Retinal fundus photograph; 45° FOV
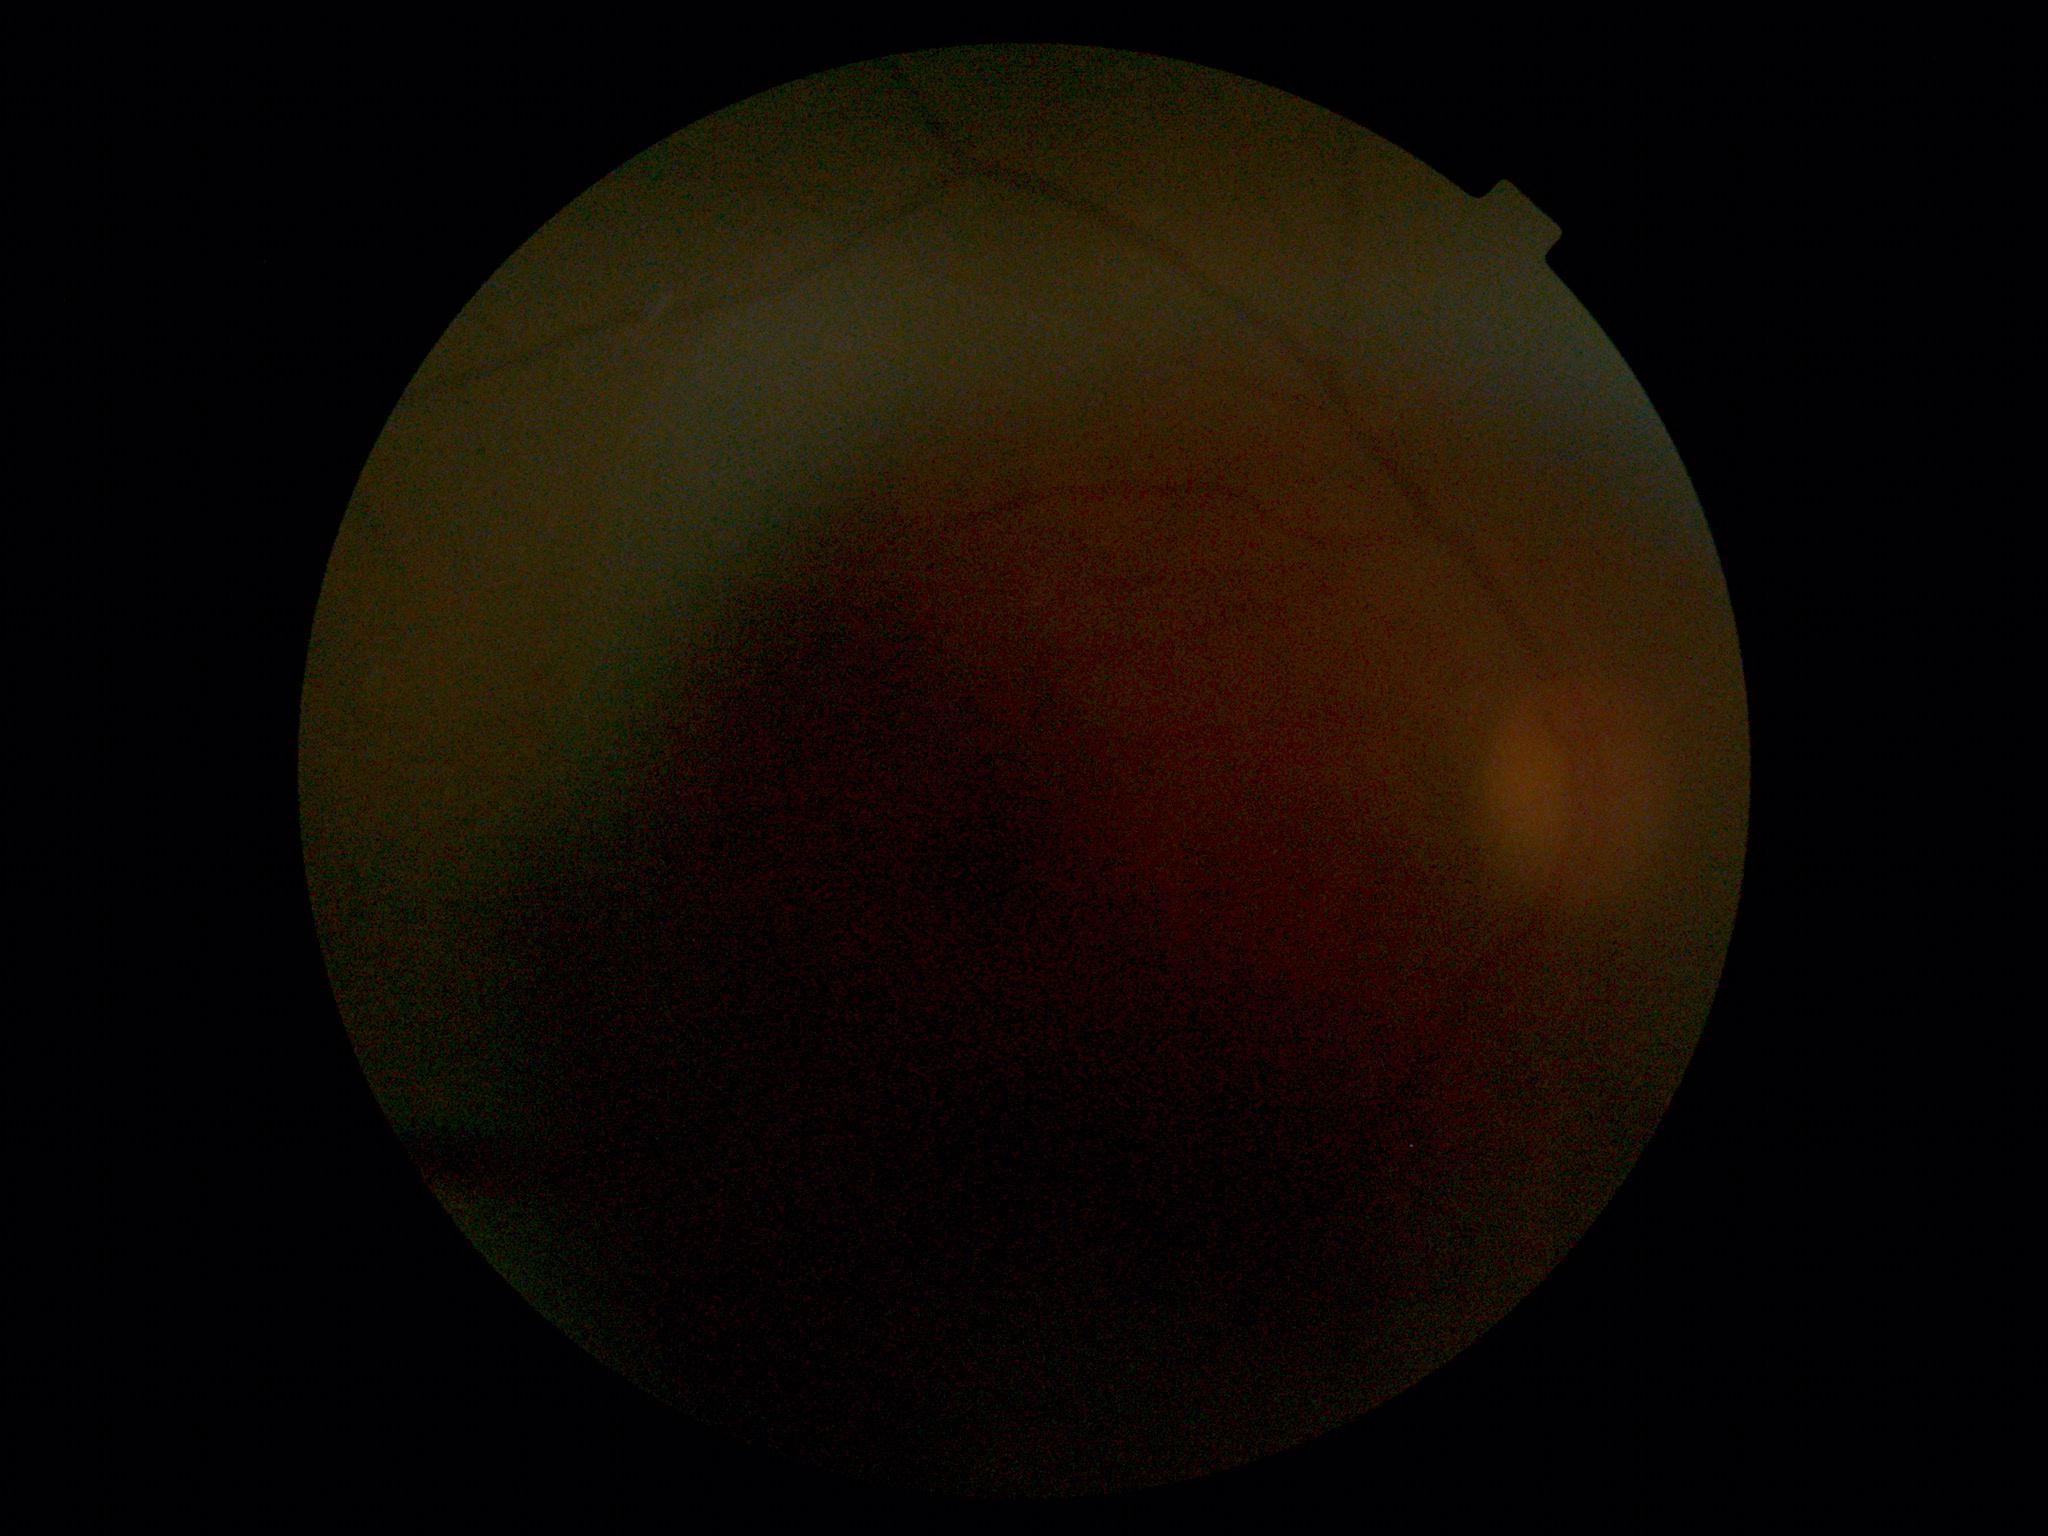 DR=ungradable.